Retinal fundus photograph:
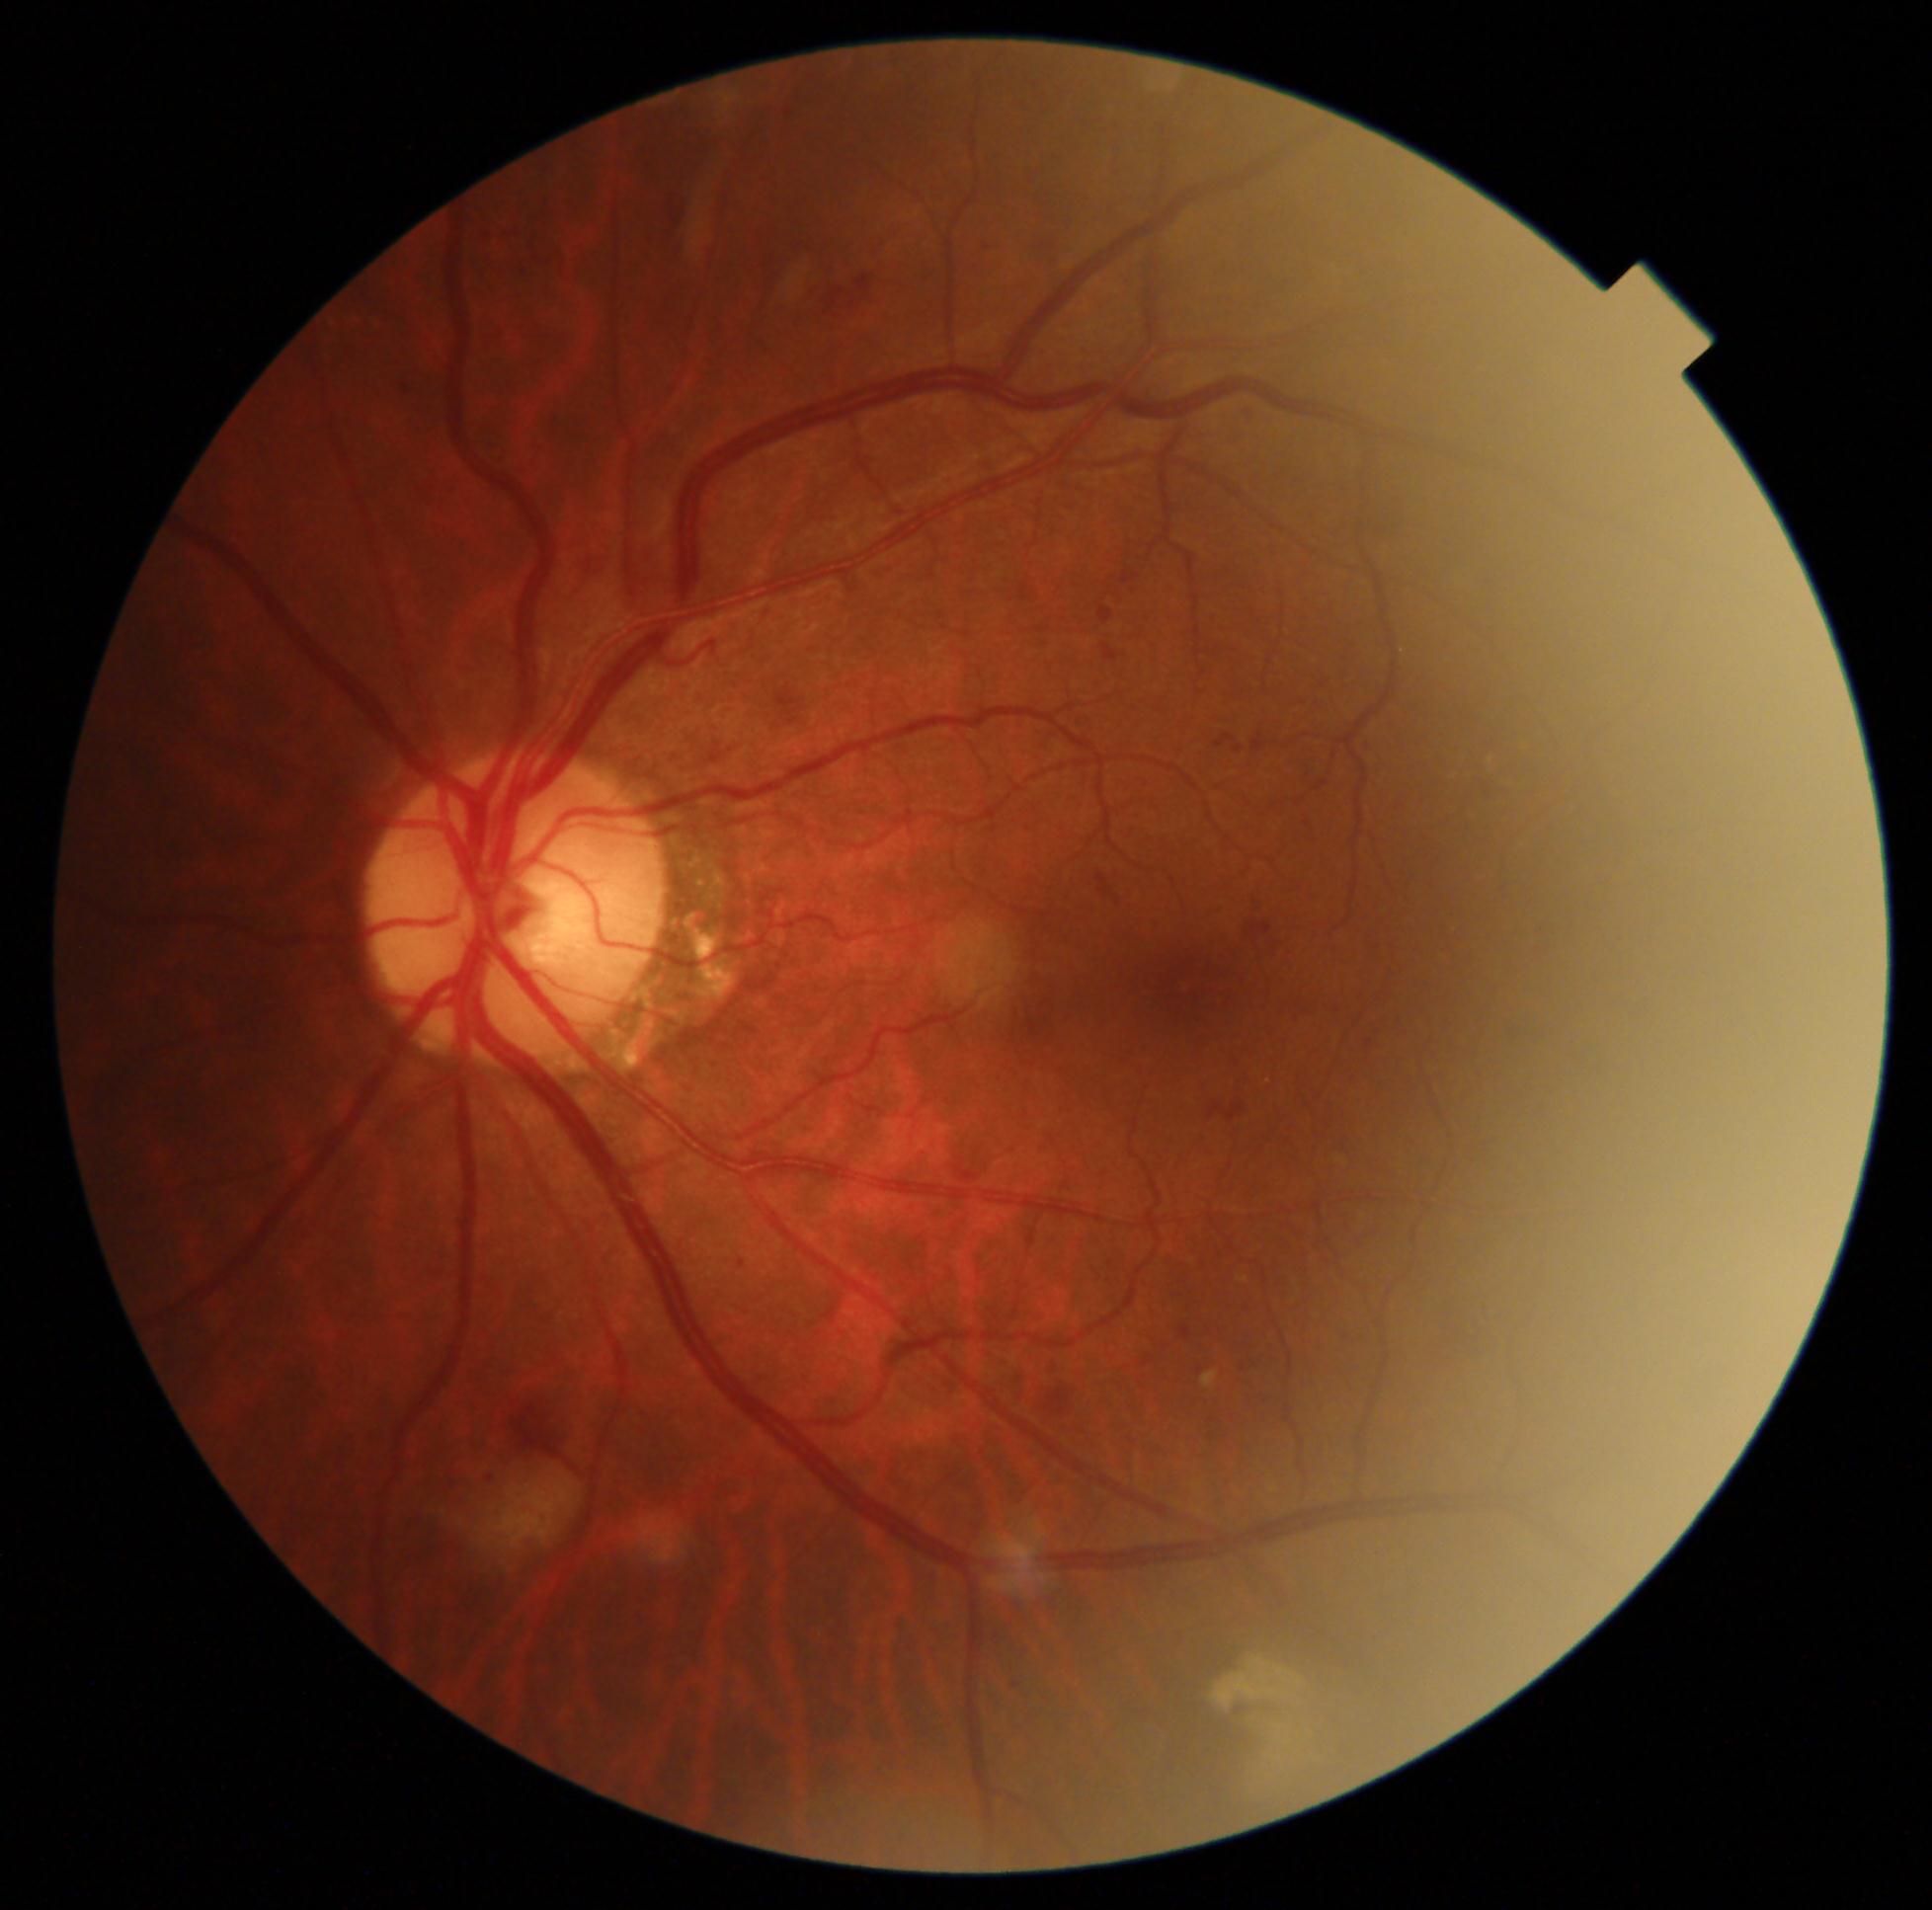 DR=grade 2 (moderate NPDR), DR class=non-proliferative diabetic retinopathy.